Acquired with a Topcon TRC-50DX:
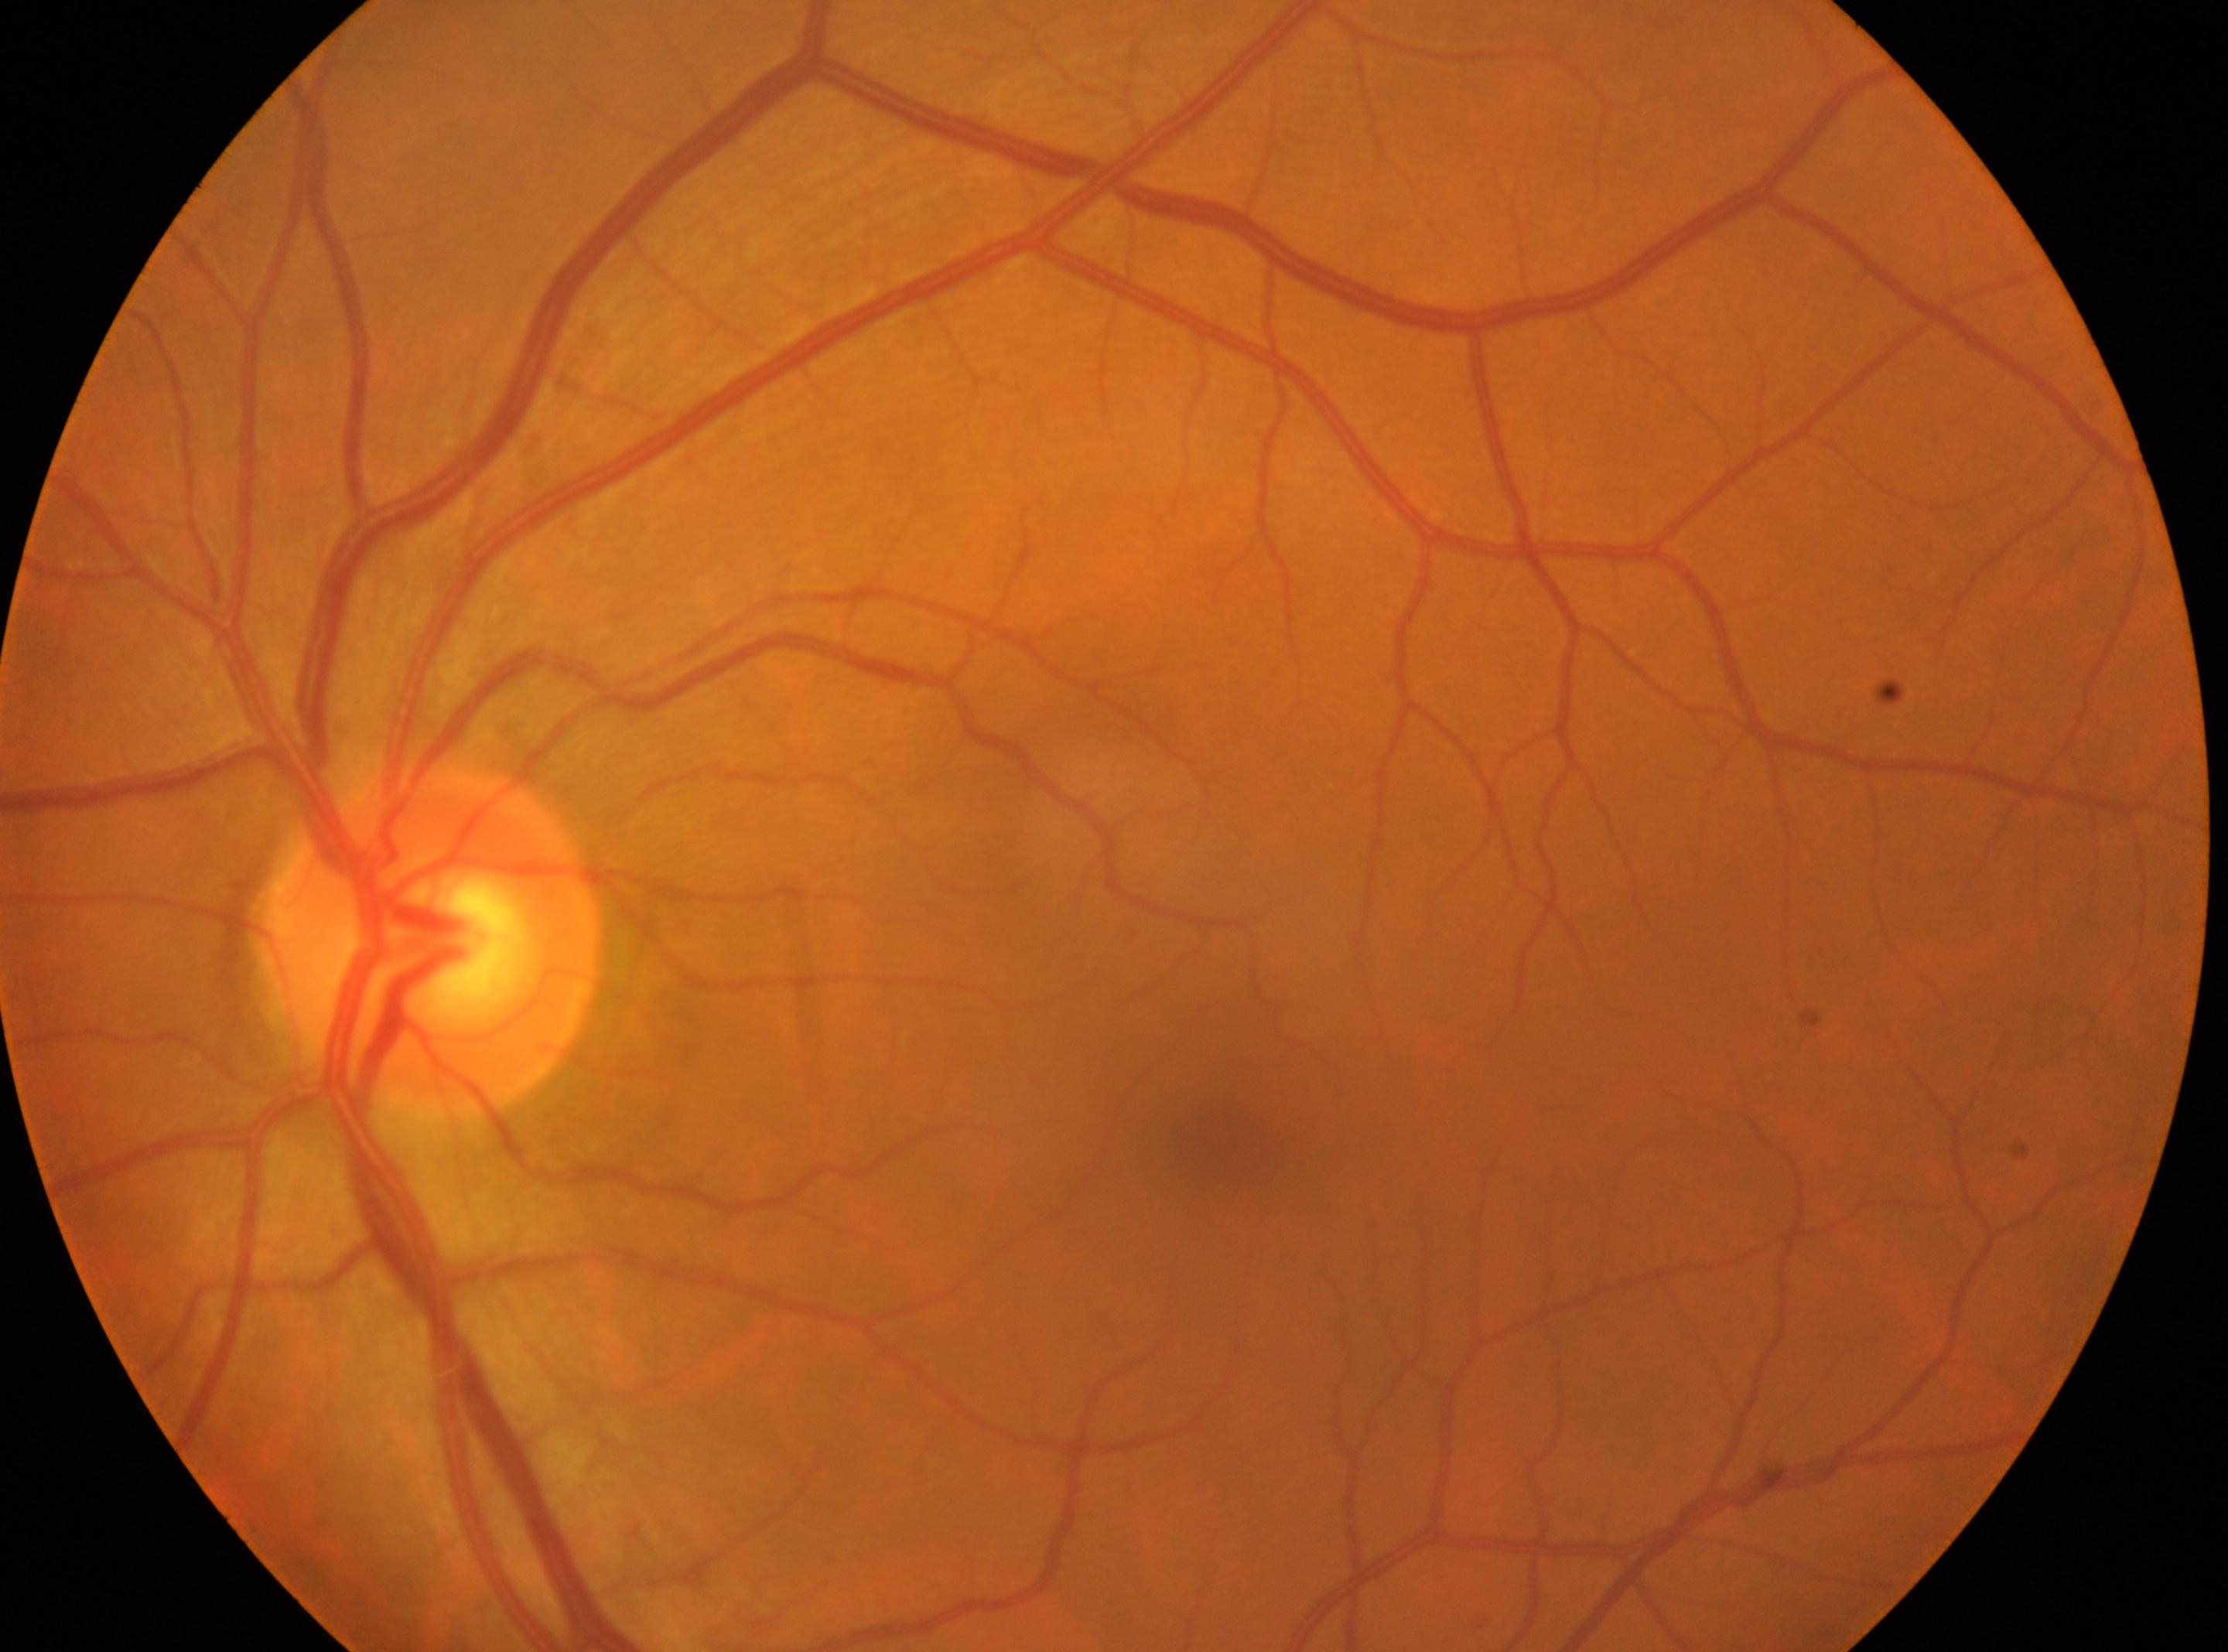
Fovea center: x=1236, y=1142. Eye: left eye. Optic disc located at x=430, y=939. Diabetic retinopathy (DR) is no apparent retinopathy (grade 0).